45-degree field of view. CFP
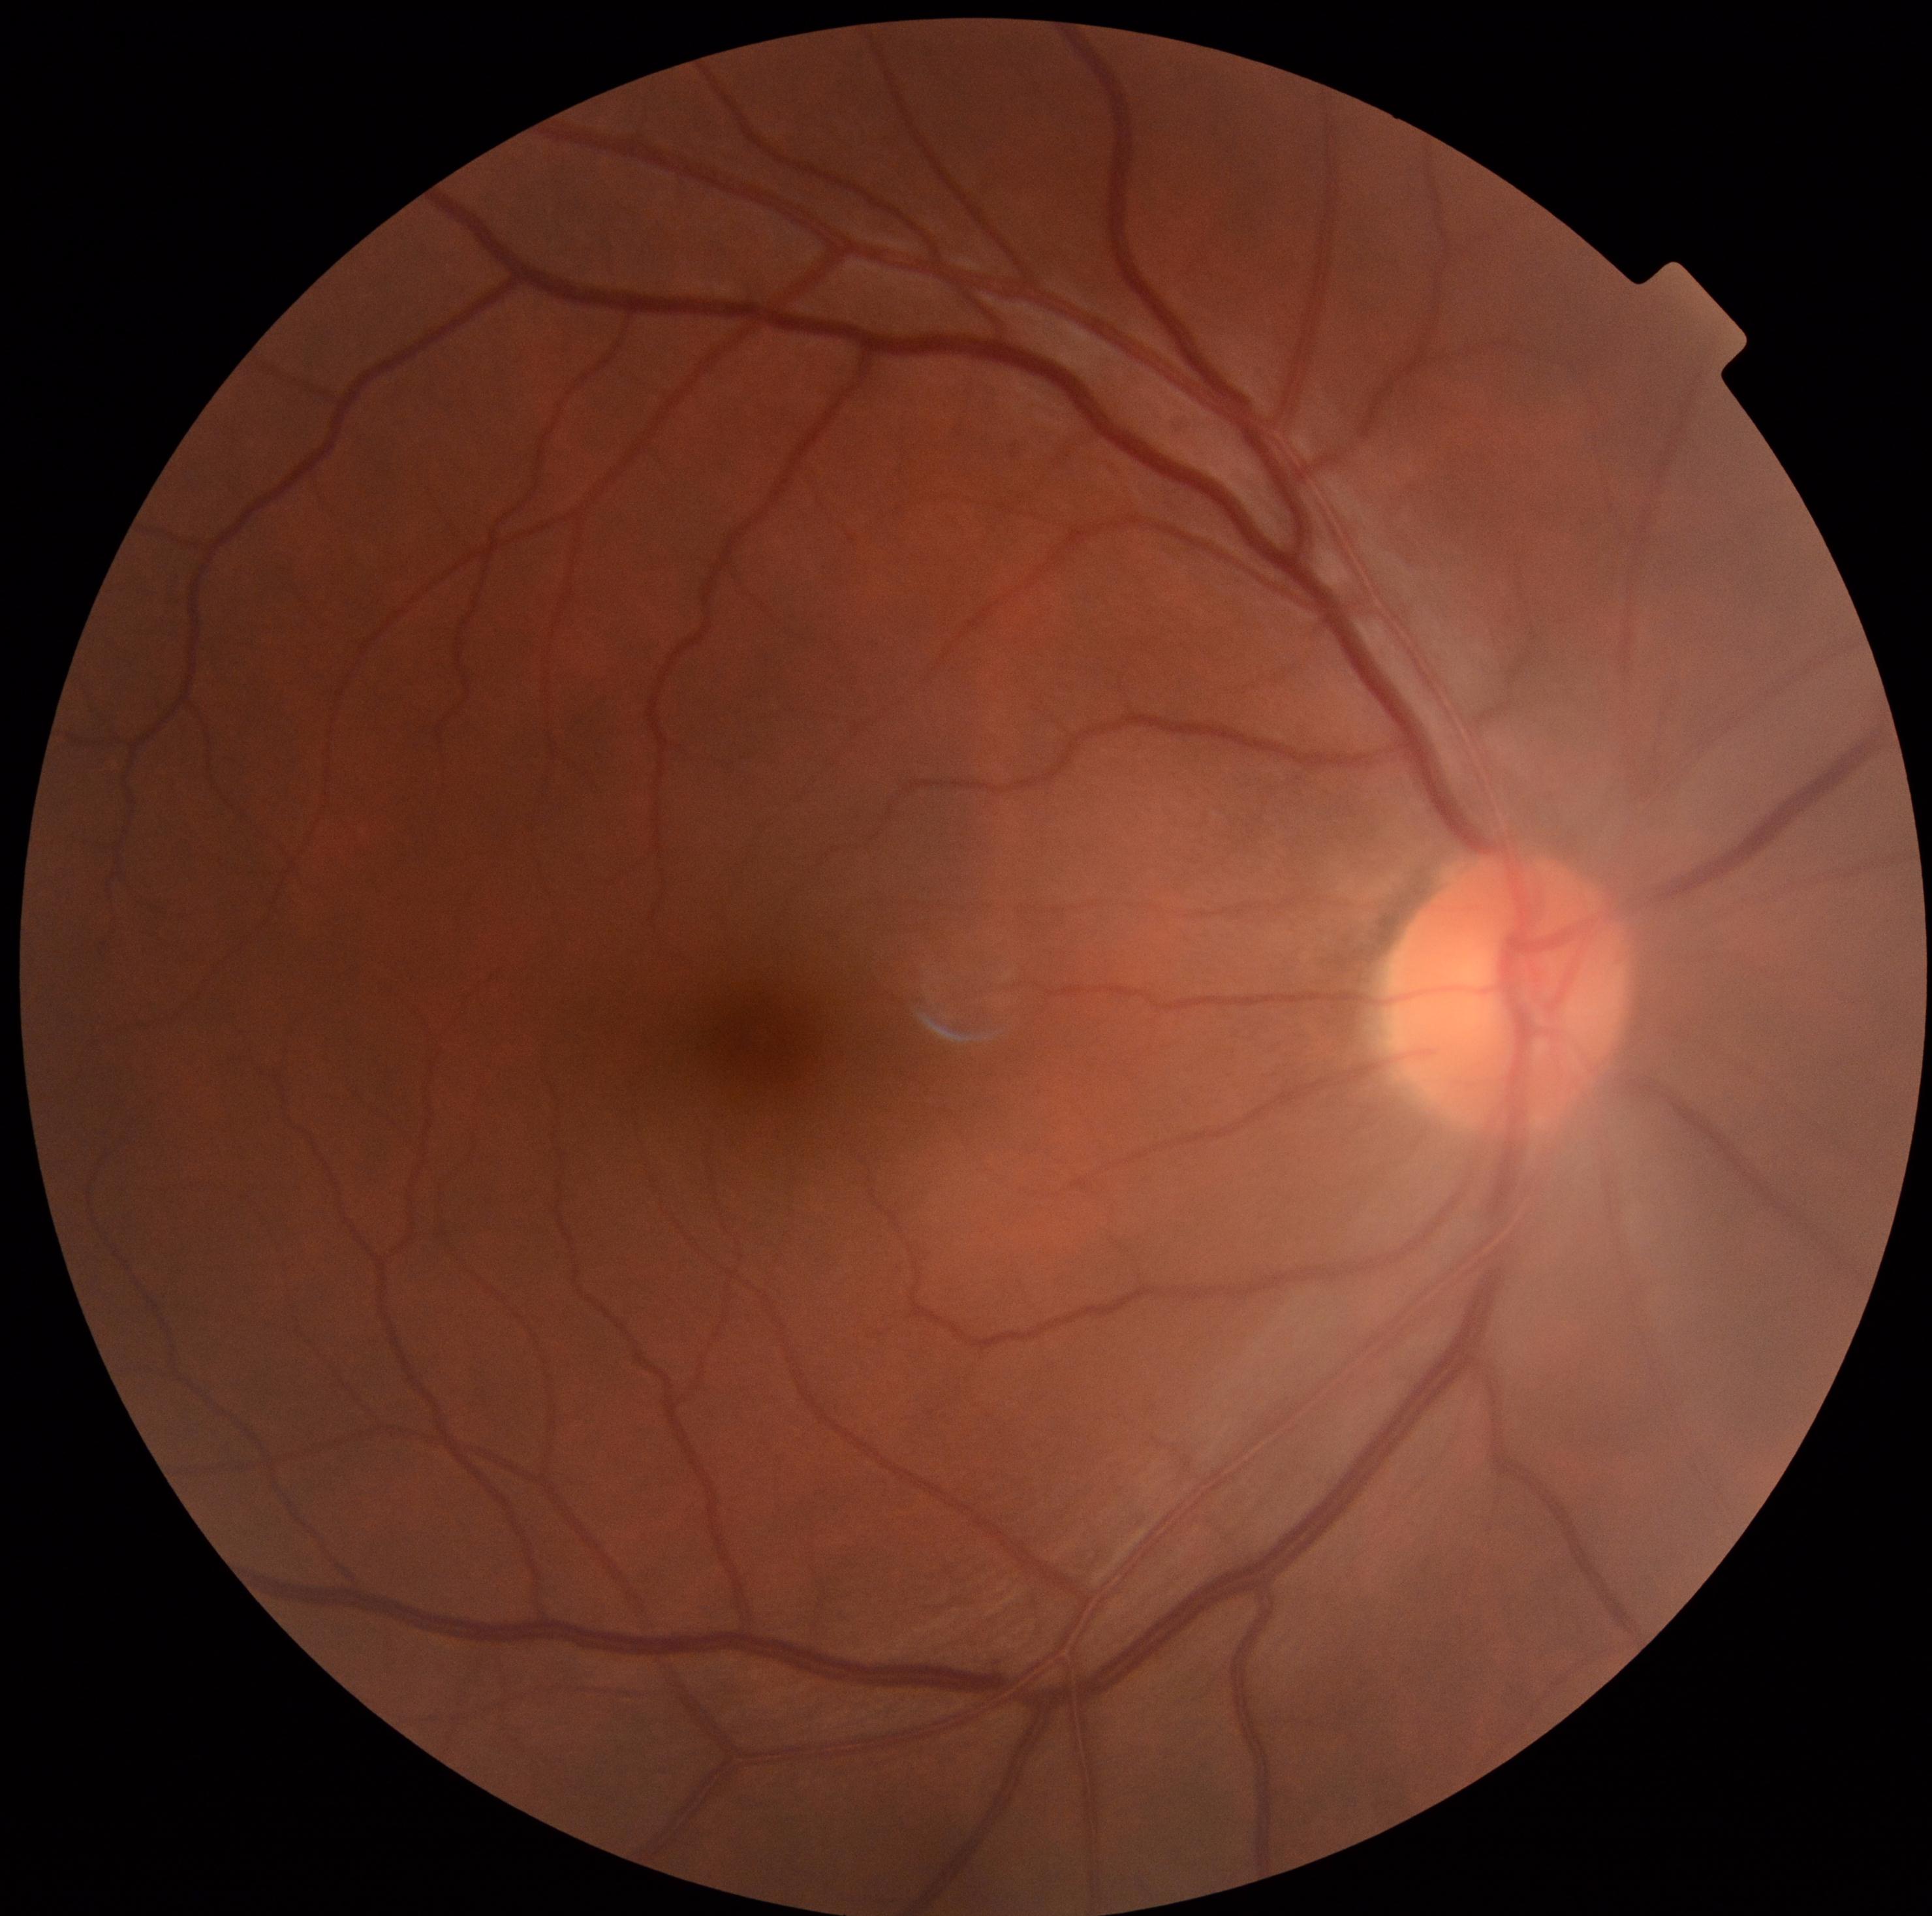 dr_grade: grade 0 (no apparent retinopathy)